Wide-field fundus photograph of an infant. Clarity RetCam 3, 130° FOV:
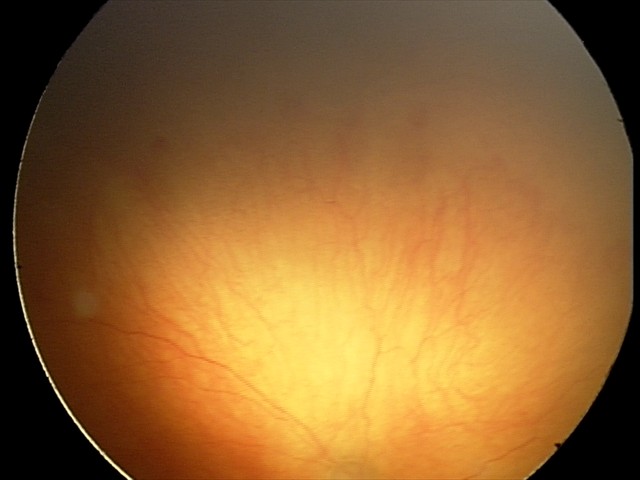

Screening examination consistent with aggressive retinopathy of prematurity (A-ROP) — rapidly progressive severe ROP with prominent plus disease, often without classic stage progression. Plus disease present.